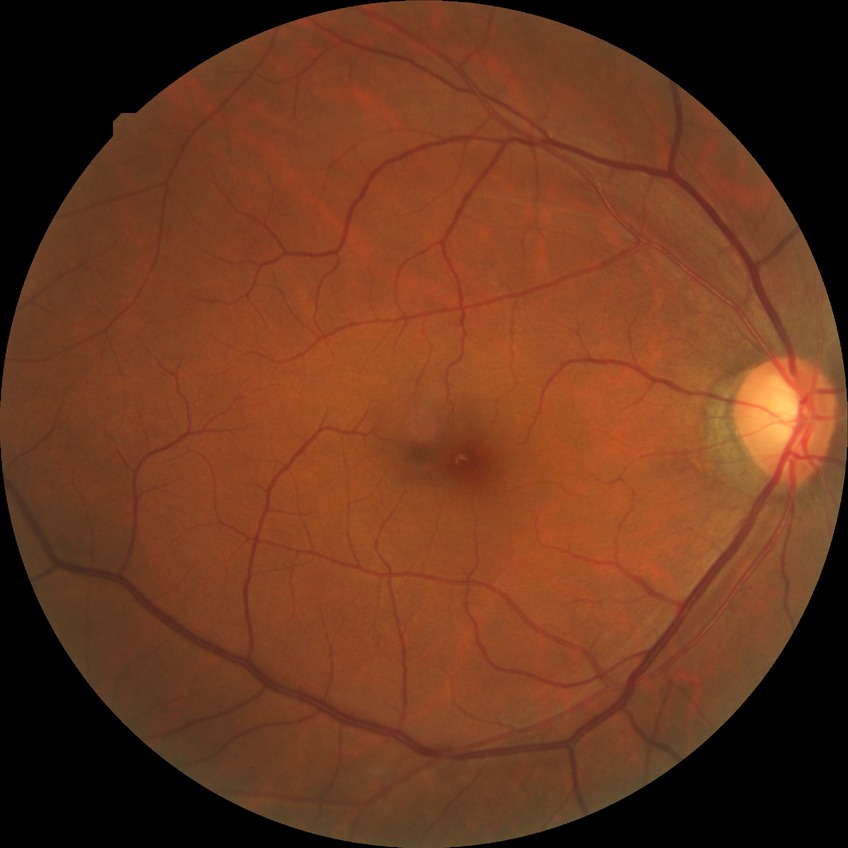 Diabetic retinopathy (DR): no diabetic retinopathy (NDR).